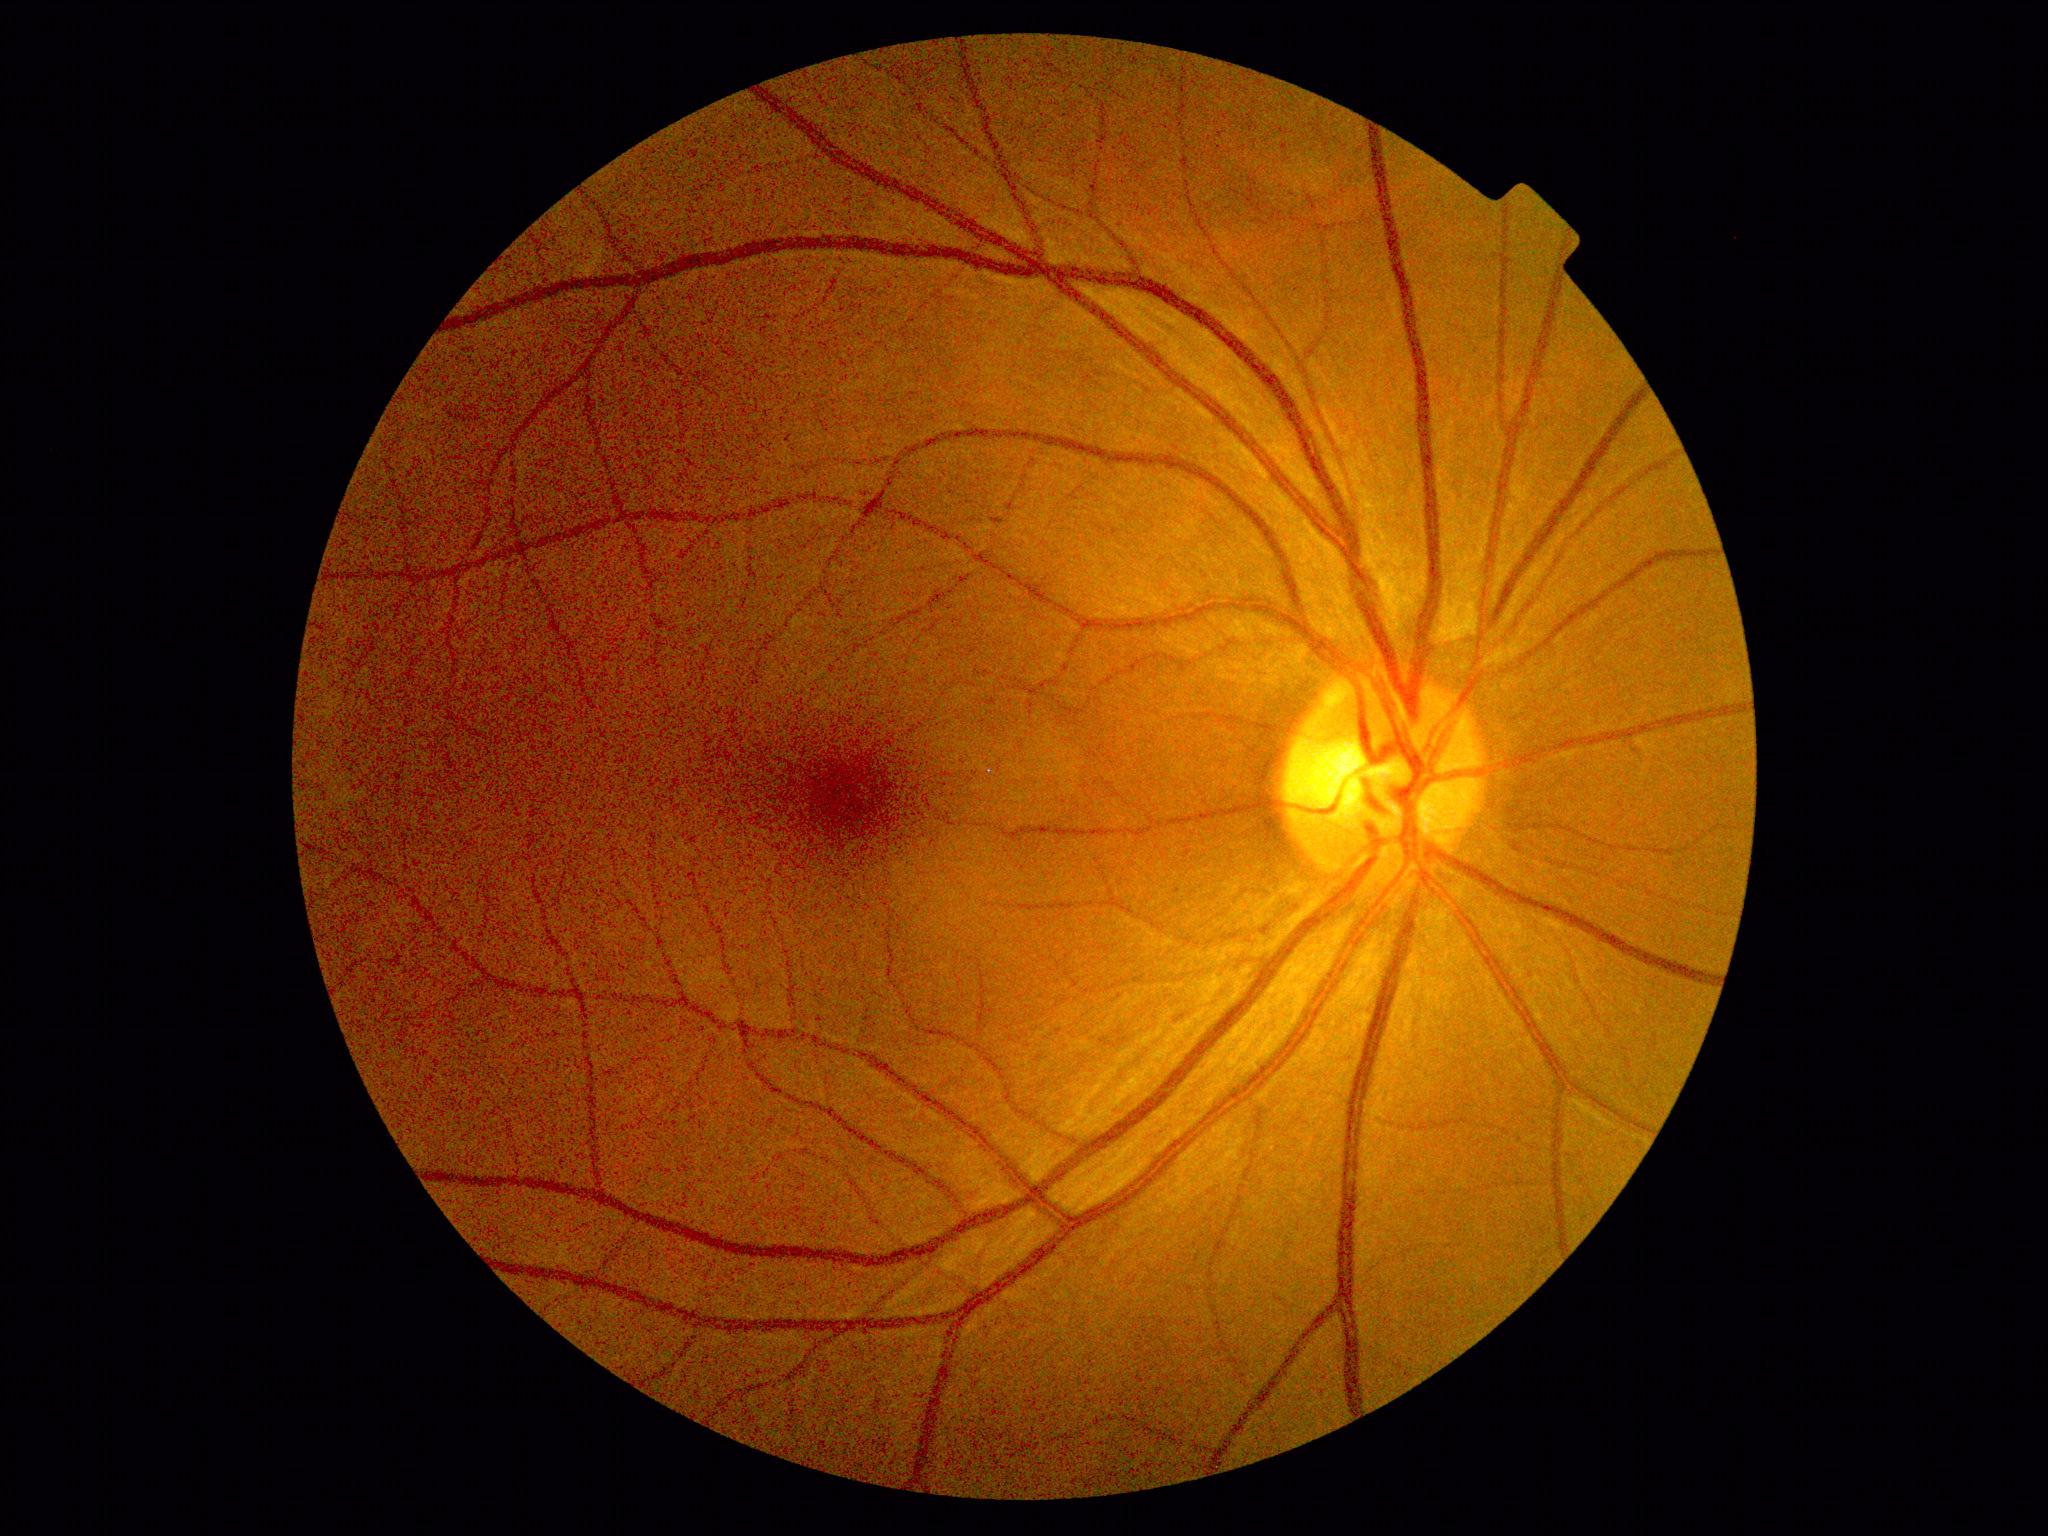
No signs of diabetic retinopathy.
DR grade is 0/4.